Wide-field fundus photograph of an infant
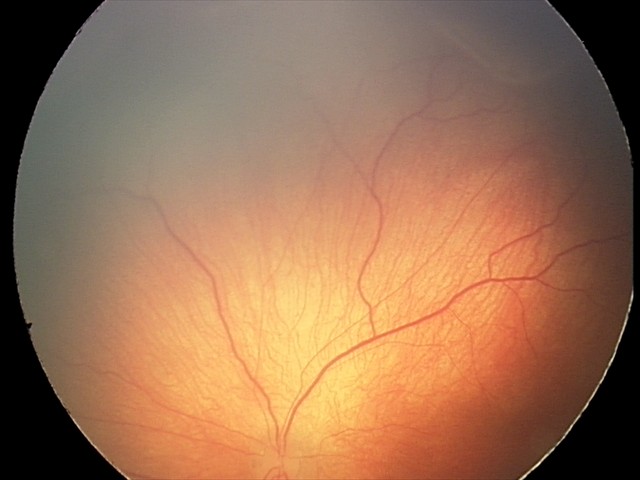
Screening examination consistent with retinopathy of prematurity stage 2.